45° FOV. Nonmydriatic fundus photograph. Retinal fundus photograph
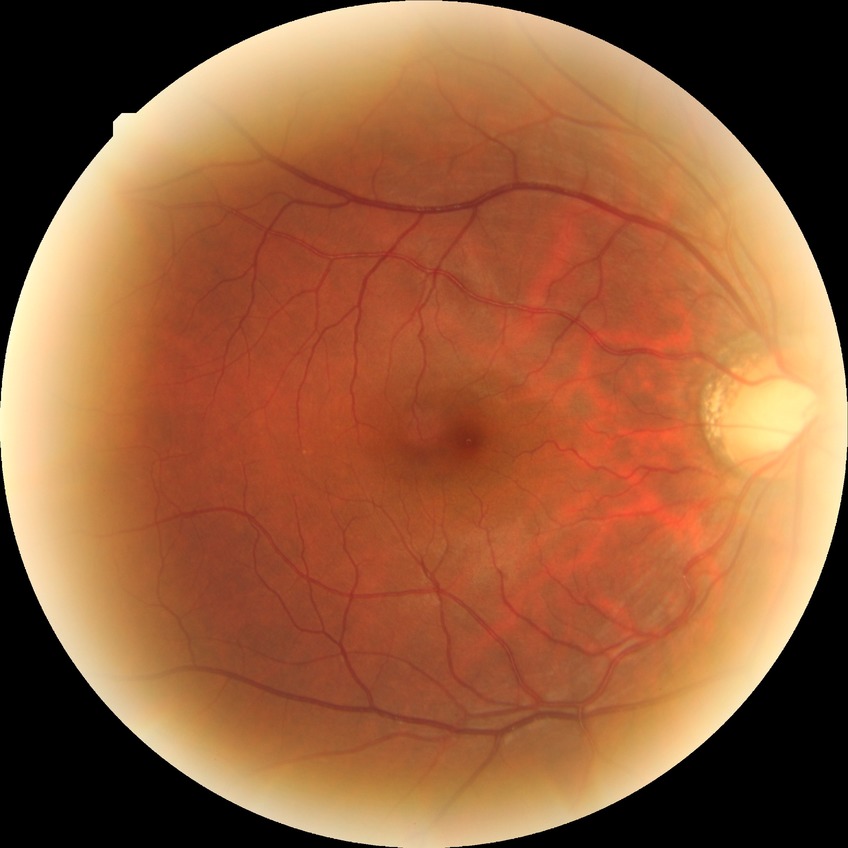 Diabetic retinopathy (DR): NDR (no diabetic retinopathy).